Wide-field contact fundus photograph of an infant. 640 x 480 pixels. Camera: Clarity RetCam 3 (130° FOV).
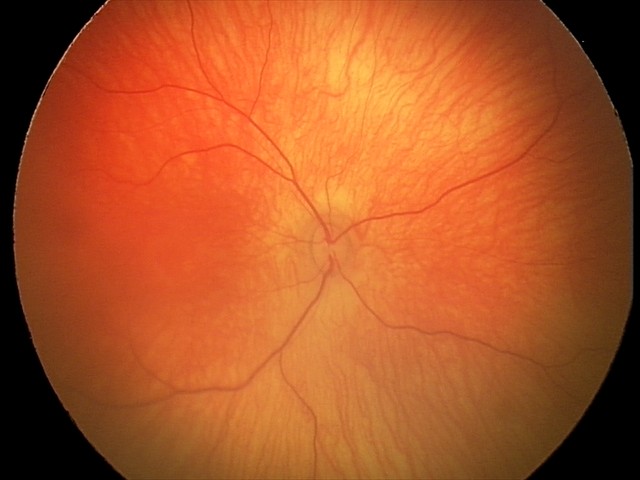 Q: What is the diagnosis from this examination?
A: physiological finding